Topcon TRC-NW400 — 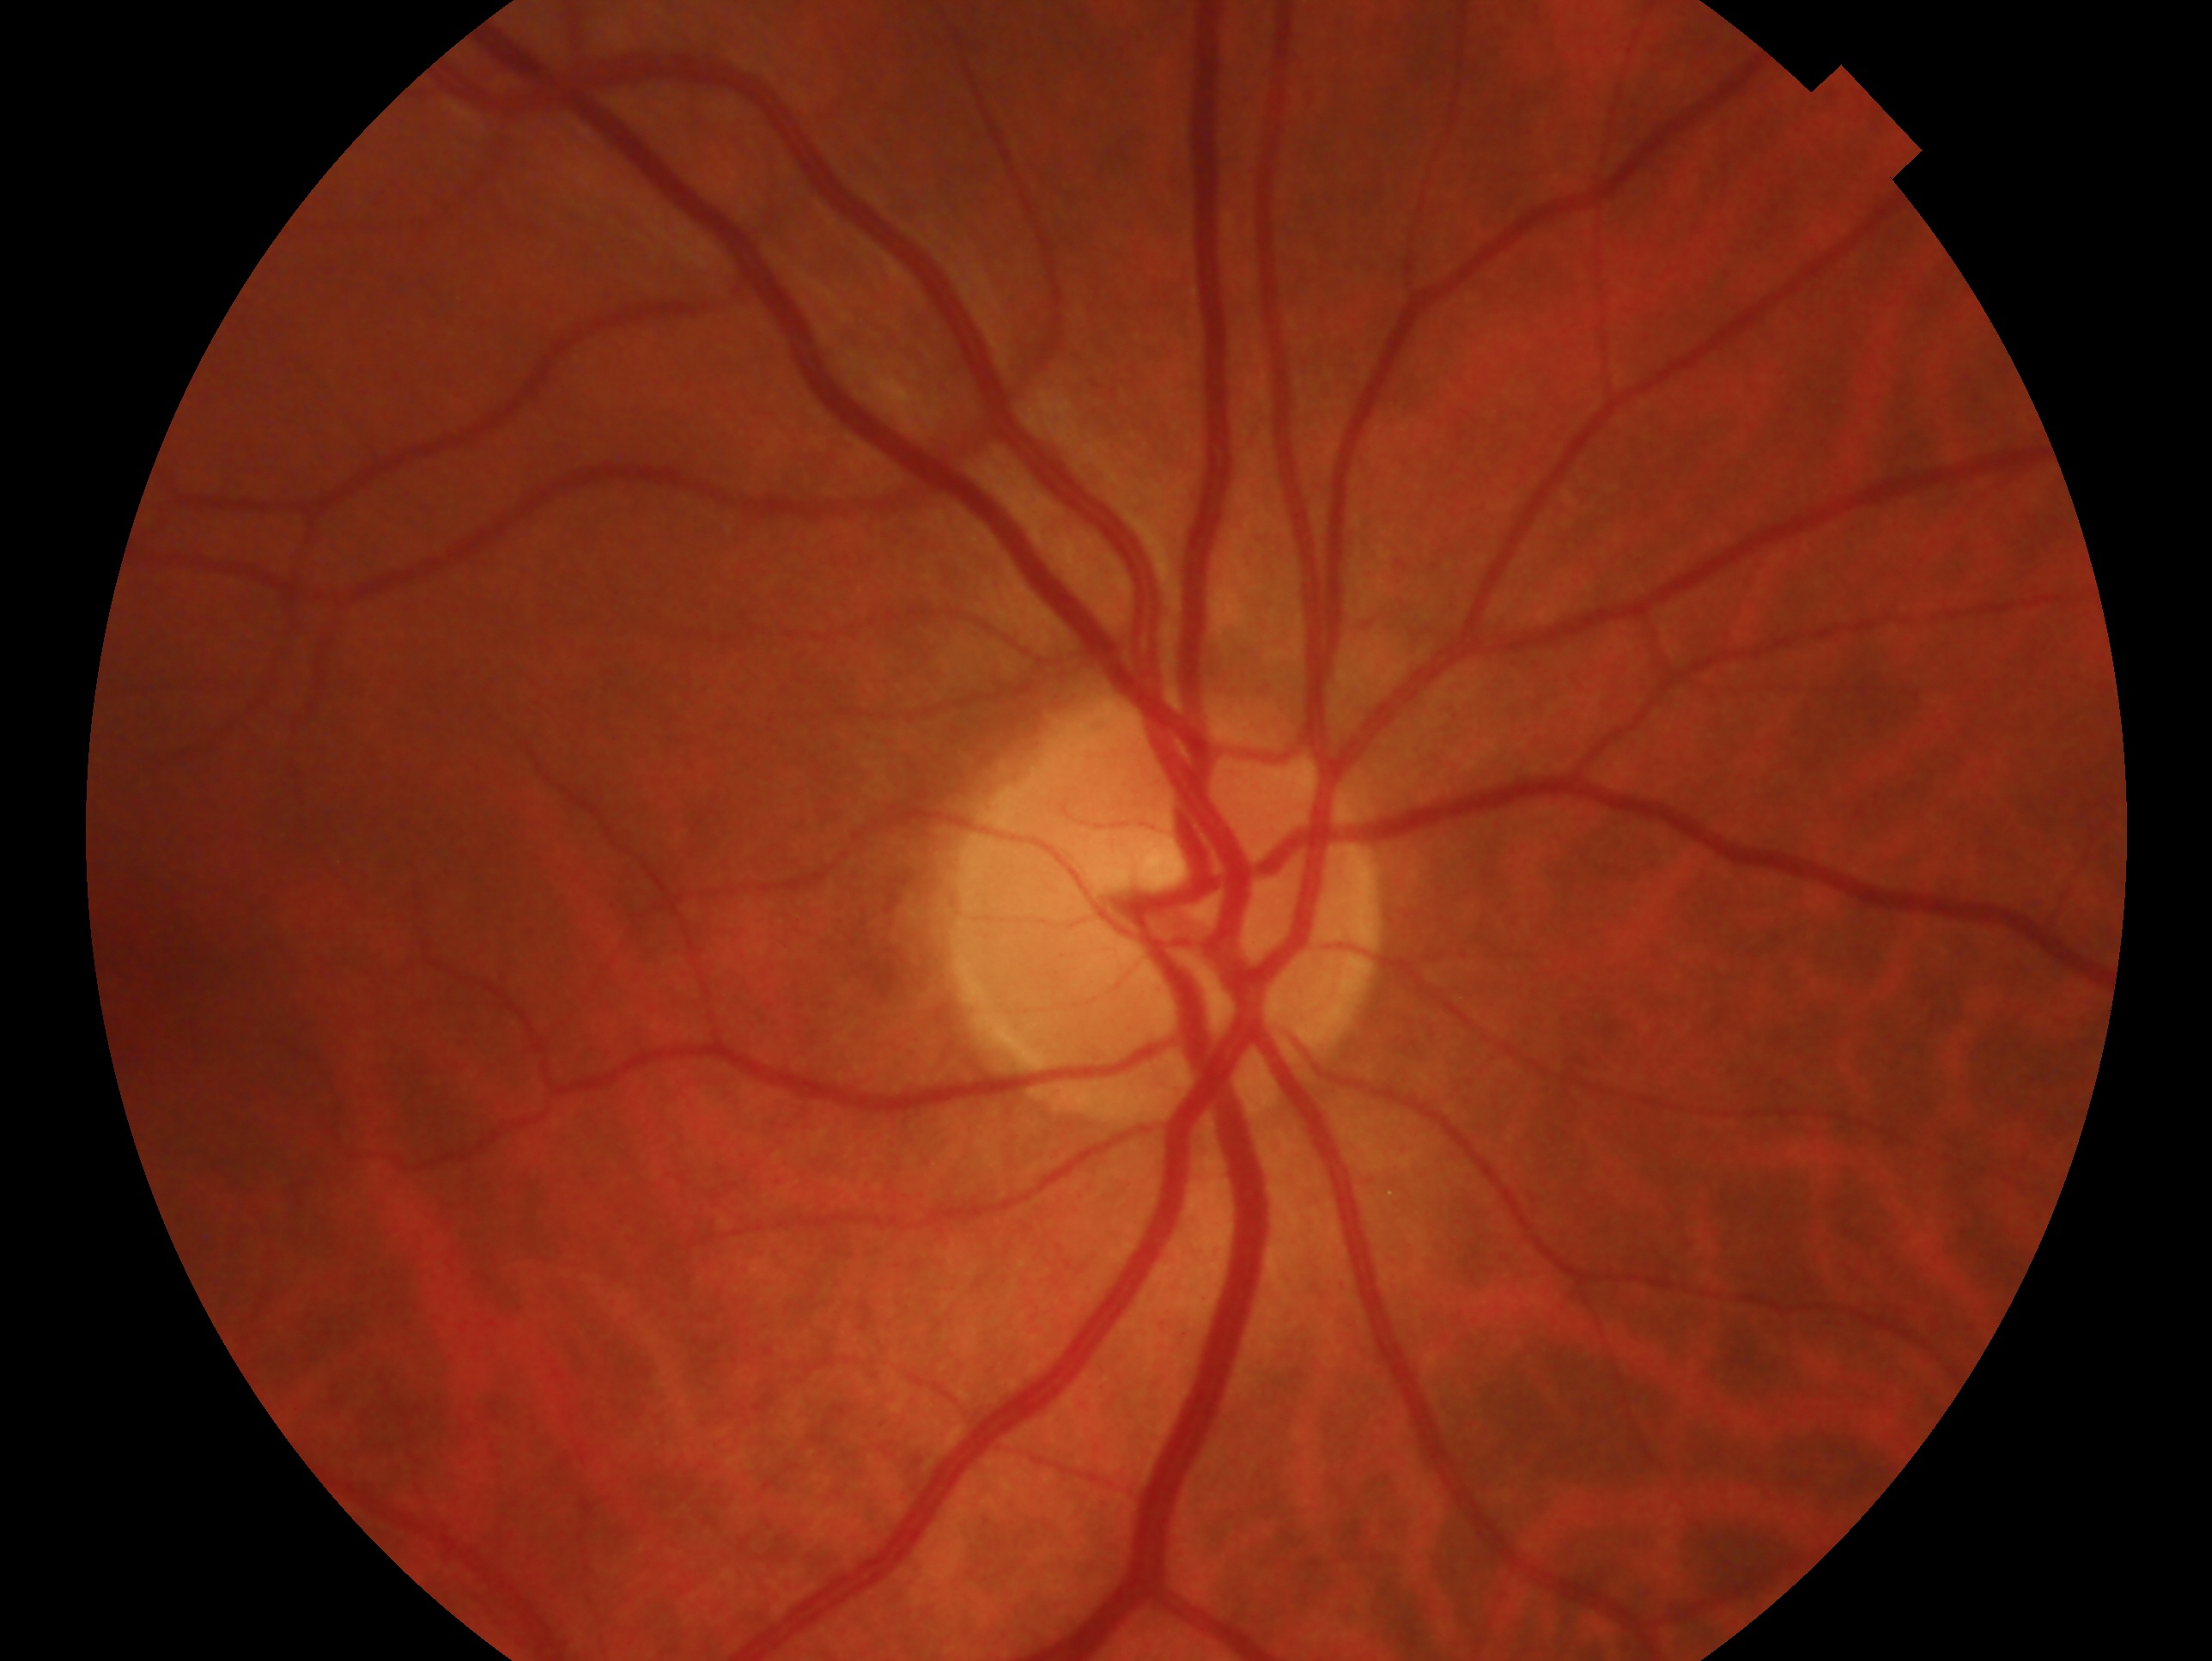

Glaucoma assessment — negative for glaucoma.
This is the OD.